Retinal fundus photograph
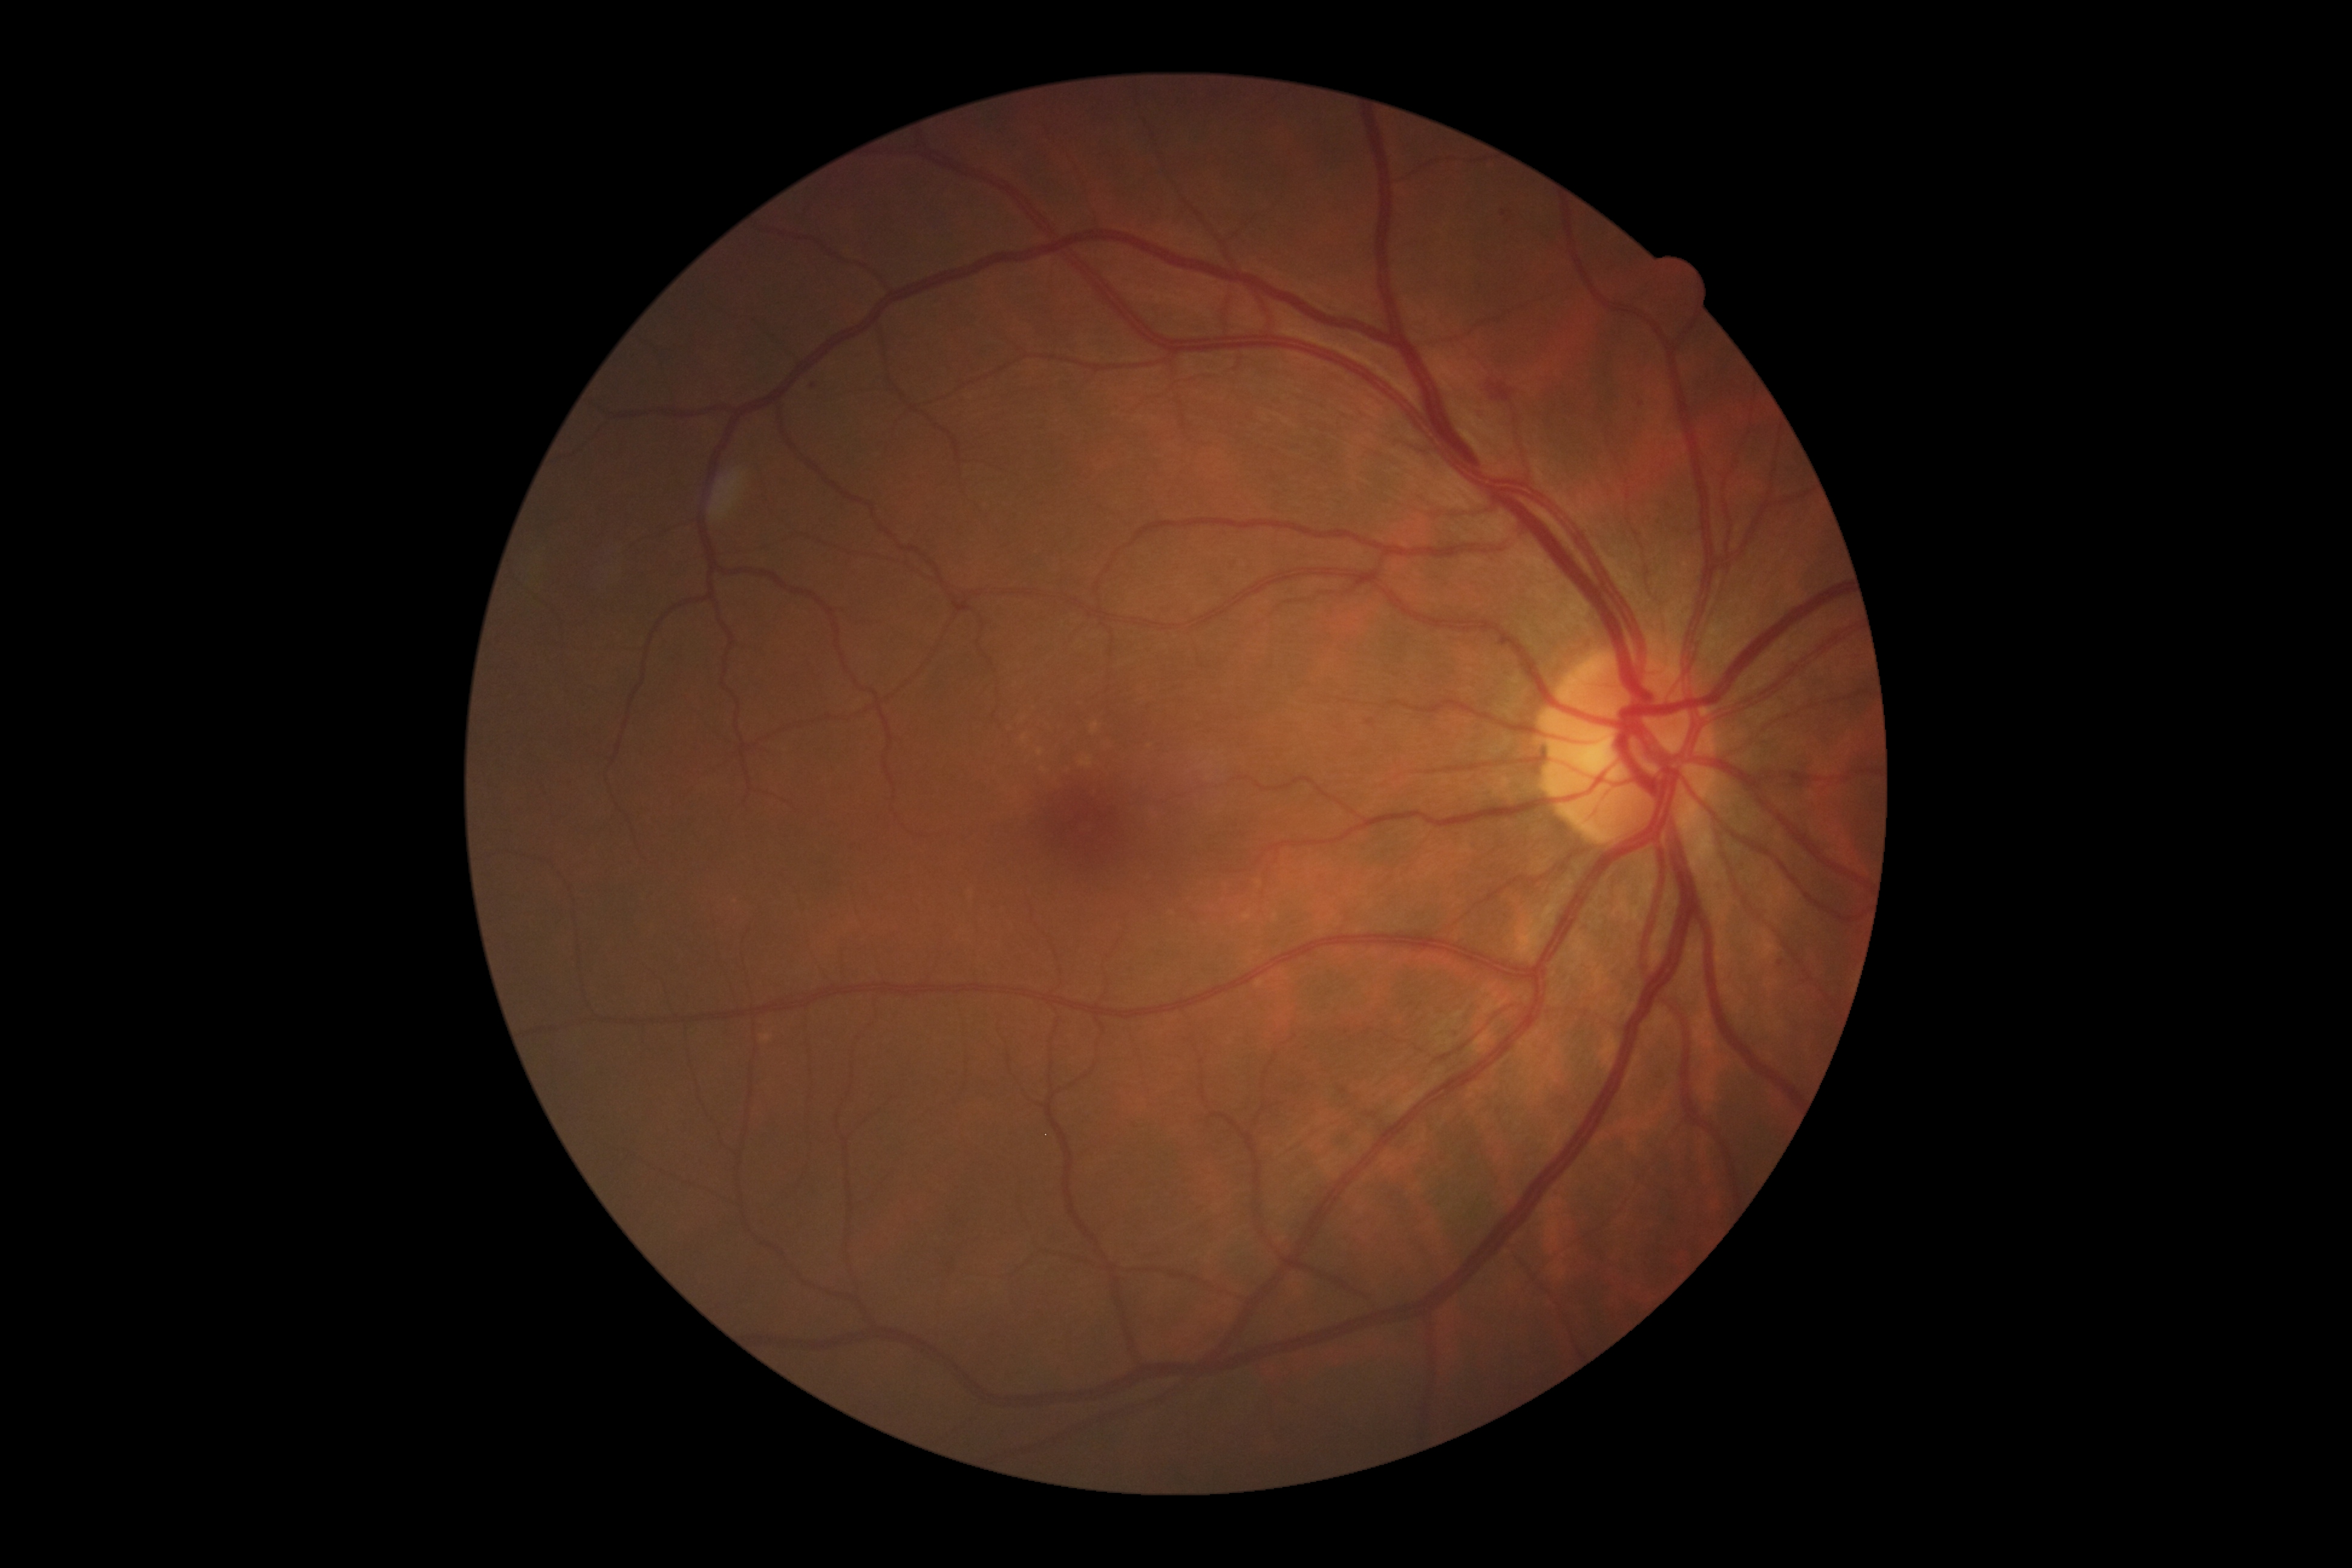

DR = 2; DR class = non-proliferative diabetic retinopathy.